Pediatric wide-field fundus photograph:
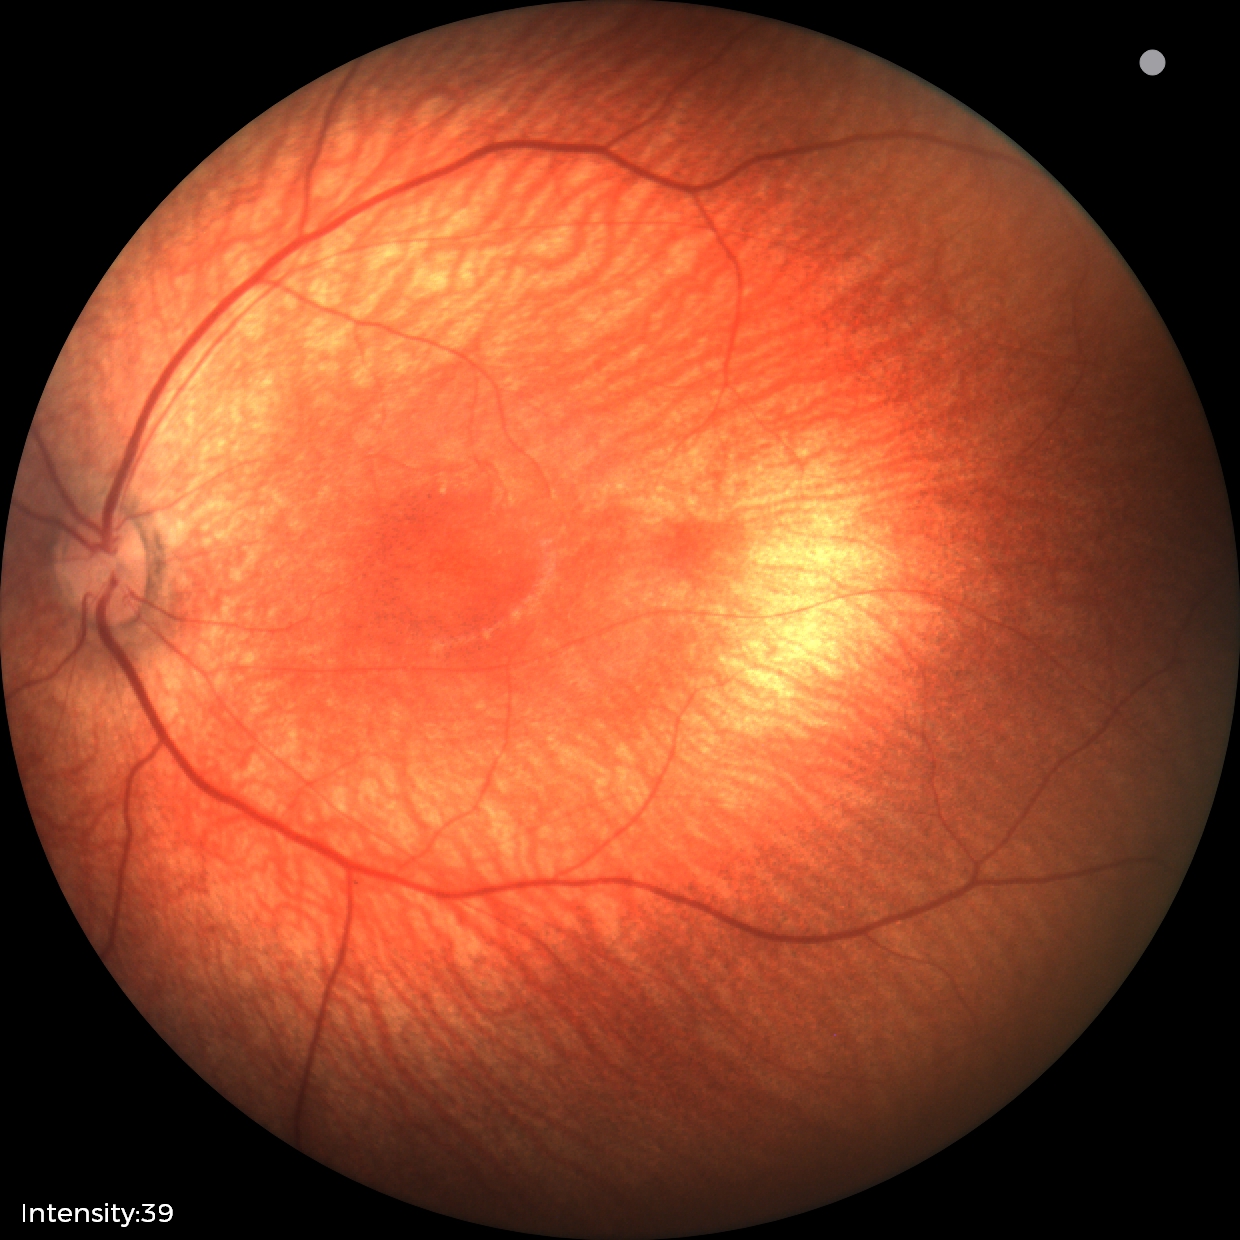

From an examination with diagnosis of retinal hemorrhages.